Posterior pole color fundus photograph · camera: NIDEK AFC-230:
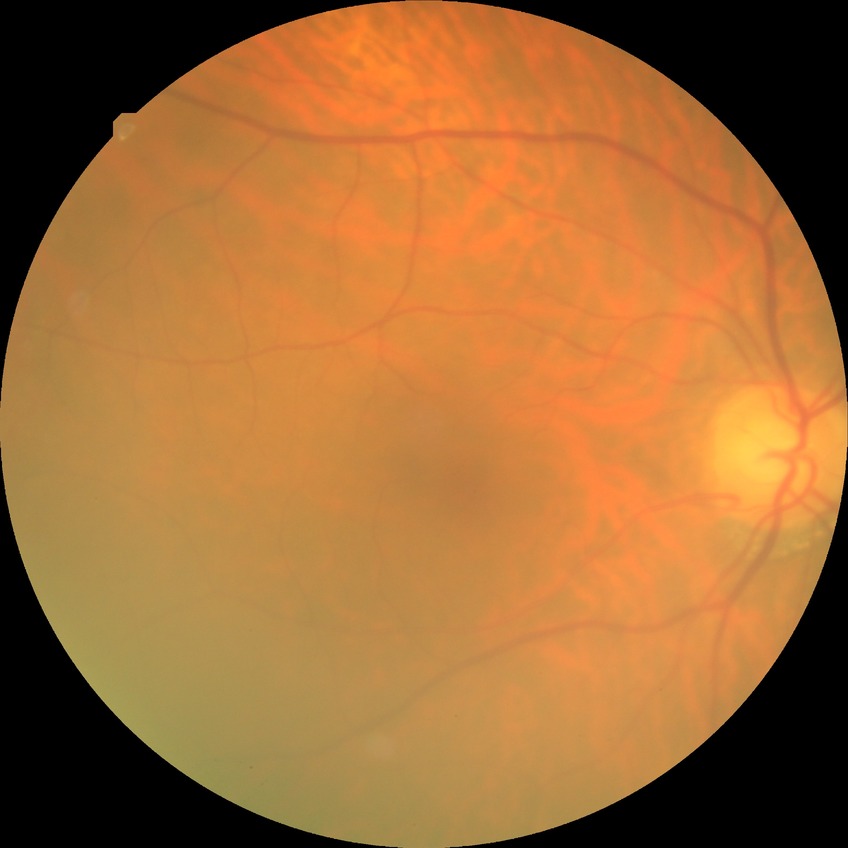

Diabetic retinopathy (DR) is NDR (no diabetic retinopathy).